45° field of view.
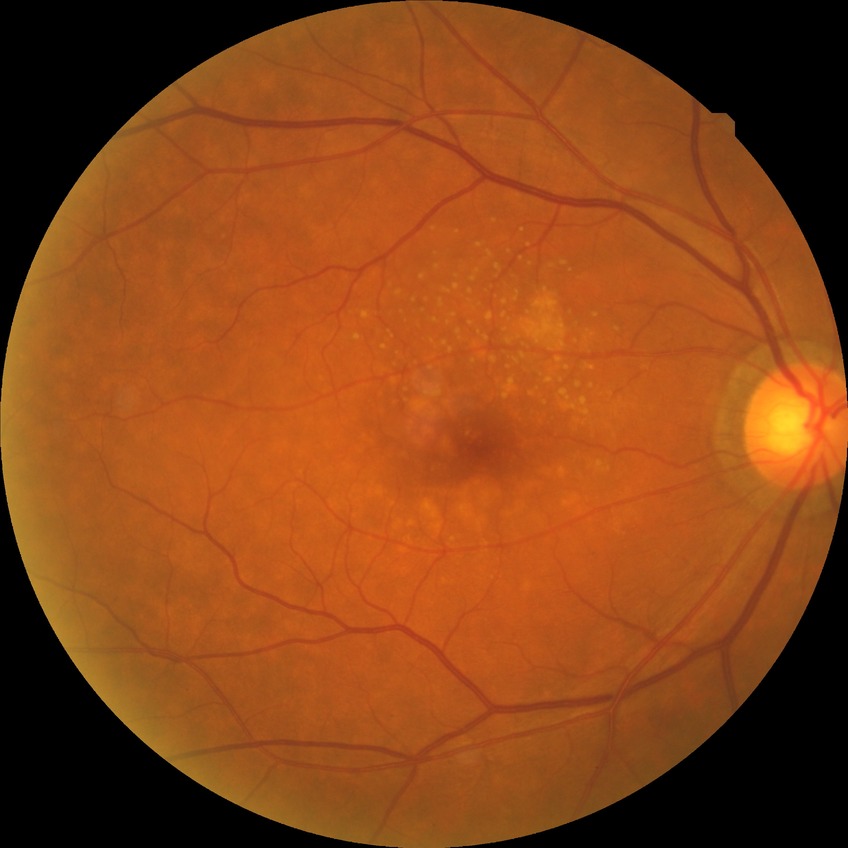 Retinopathy stage: no diabetic retinopathy.